Without pupil dilation — 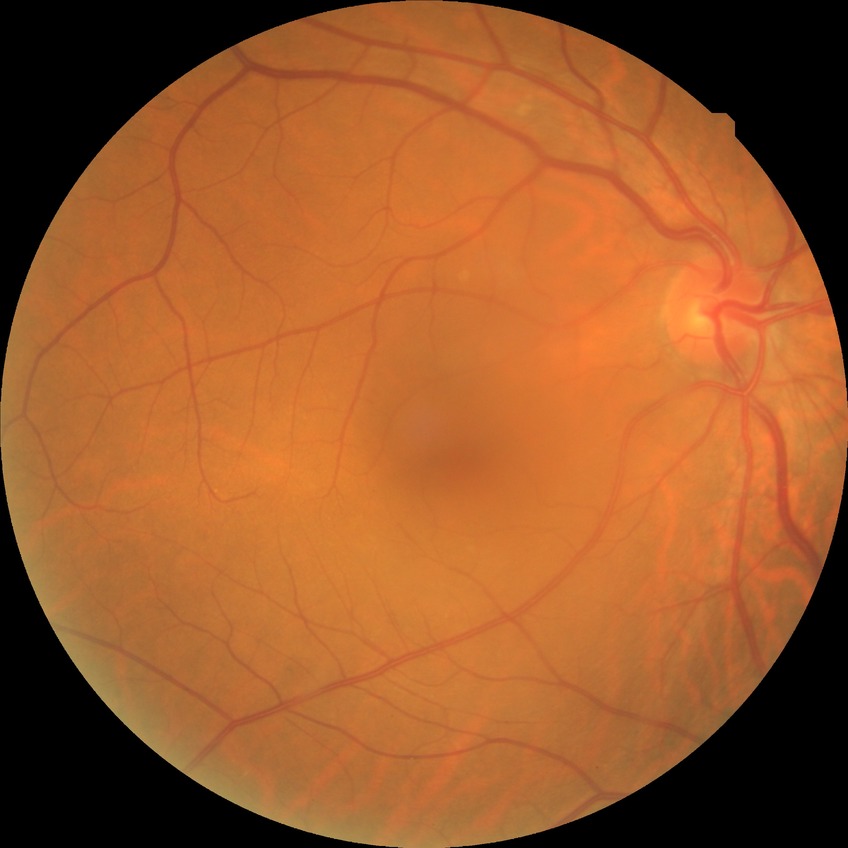 Diabetic retinopathy grade is no diabetic retinopathy.